Pediatric wide-field fundus photograph:
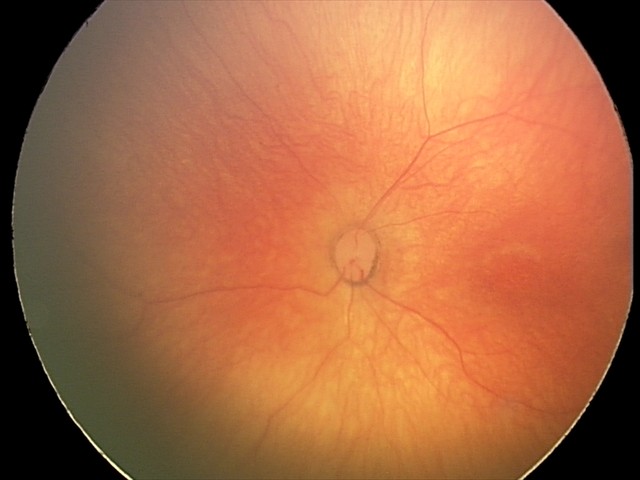
Finding: normal retinal appearance.